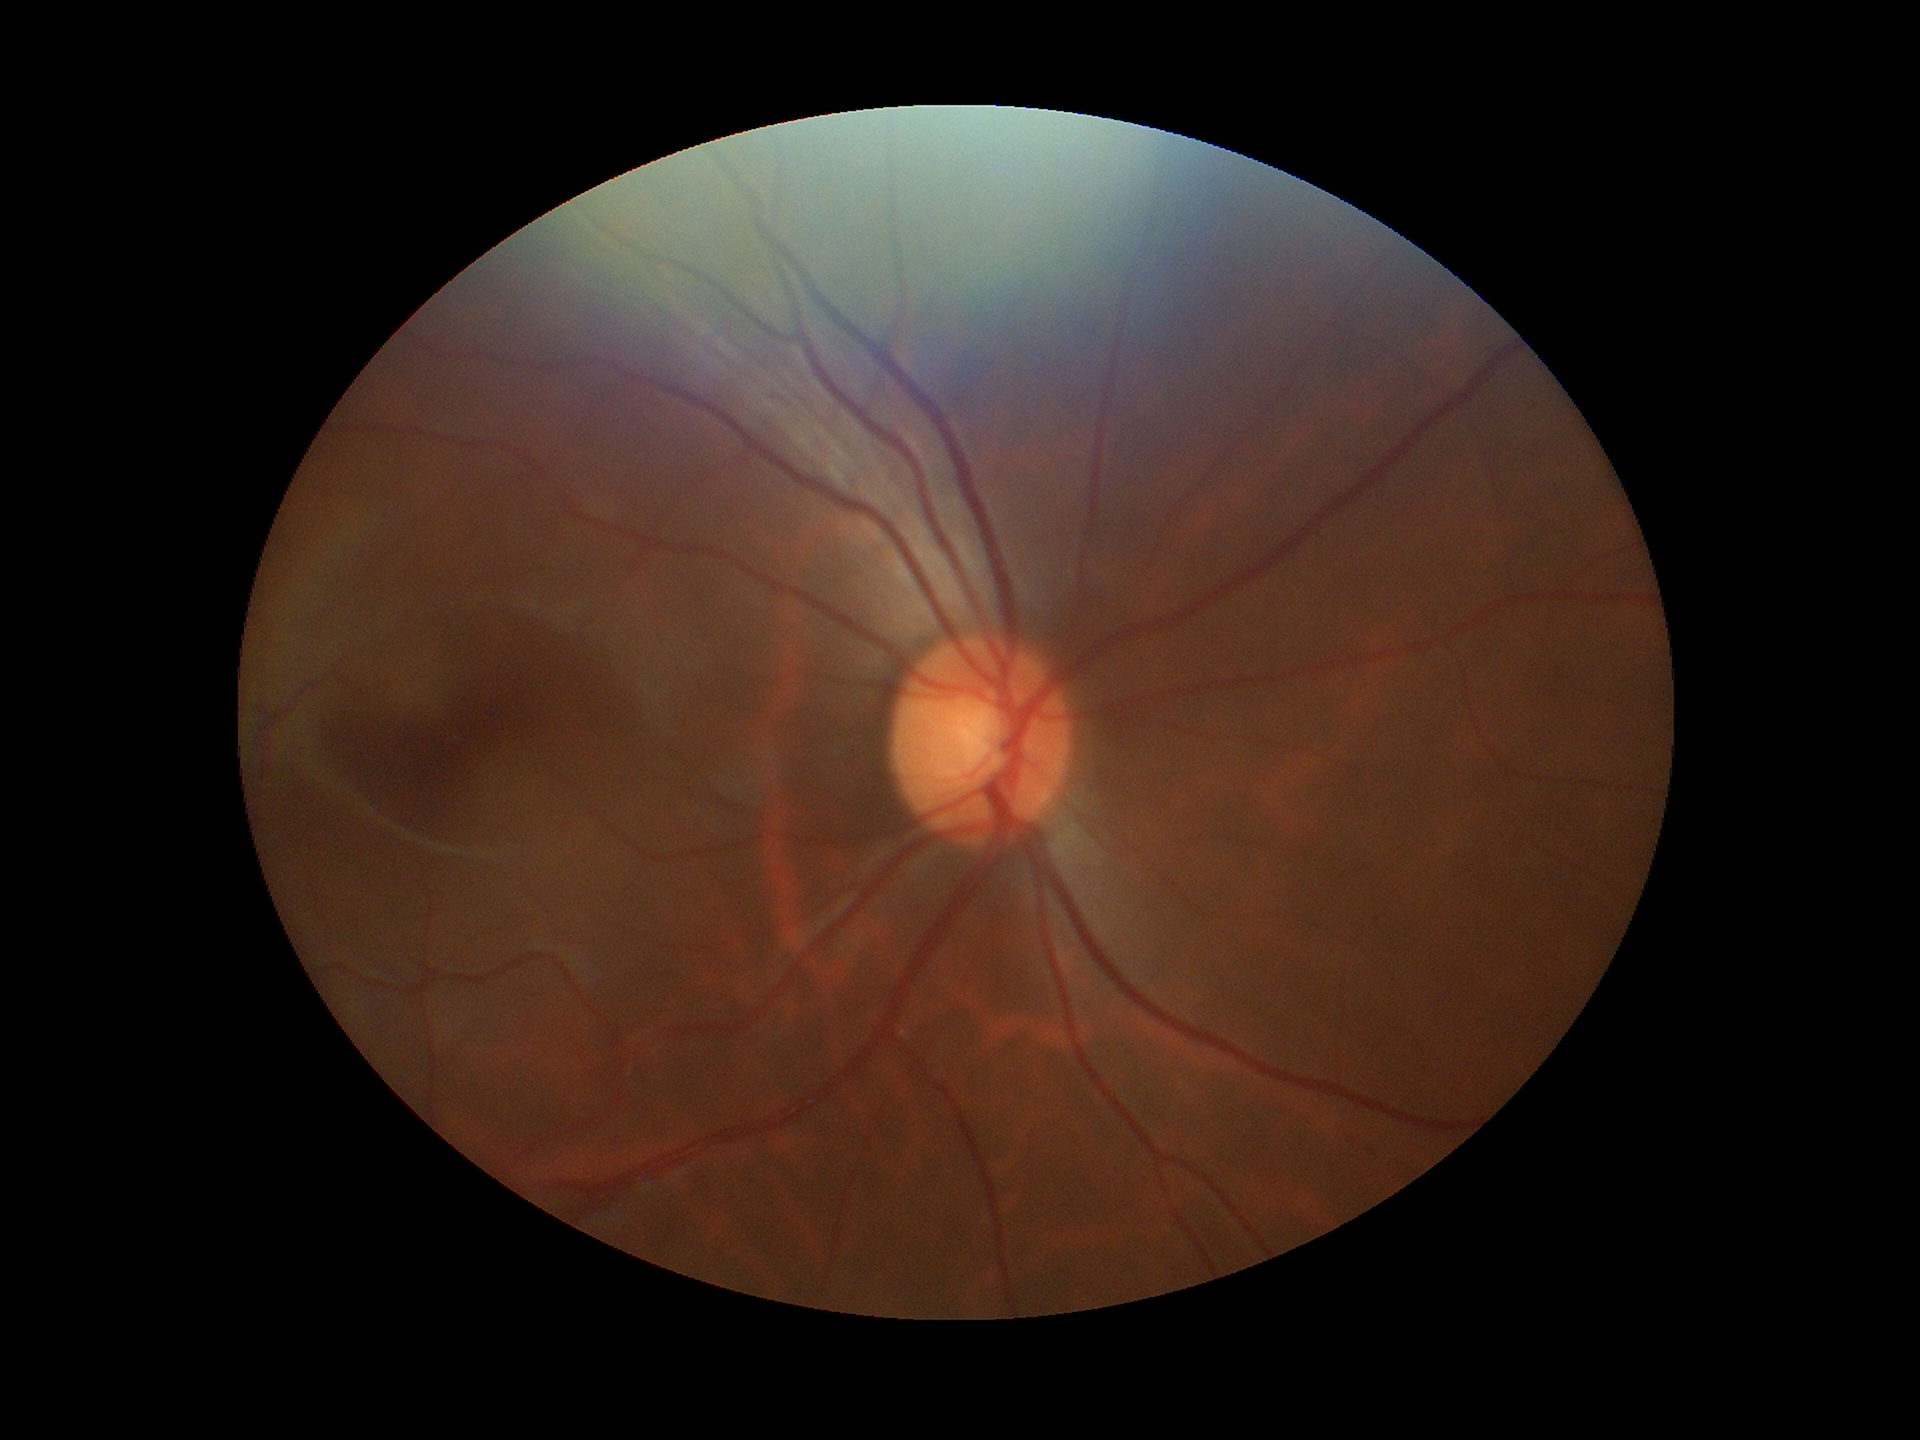
Negative for glaucoma suspicion (5/5 ophthalmologists in agreement).
Vertical cup-disc ratio (VCDR) of 0.51.
Area CDR (ACDR) is 0.25.